Topcon TRC-50DX; captured after pupil dilation; 2228 by 1652 pixels:
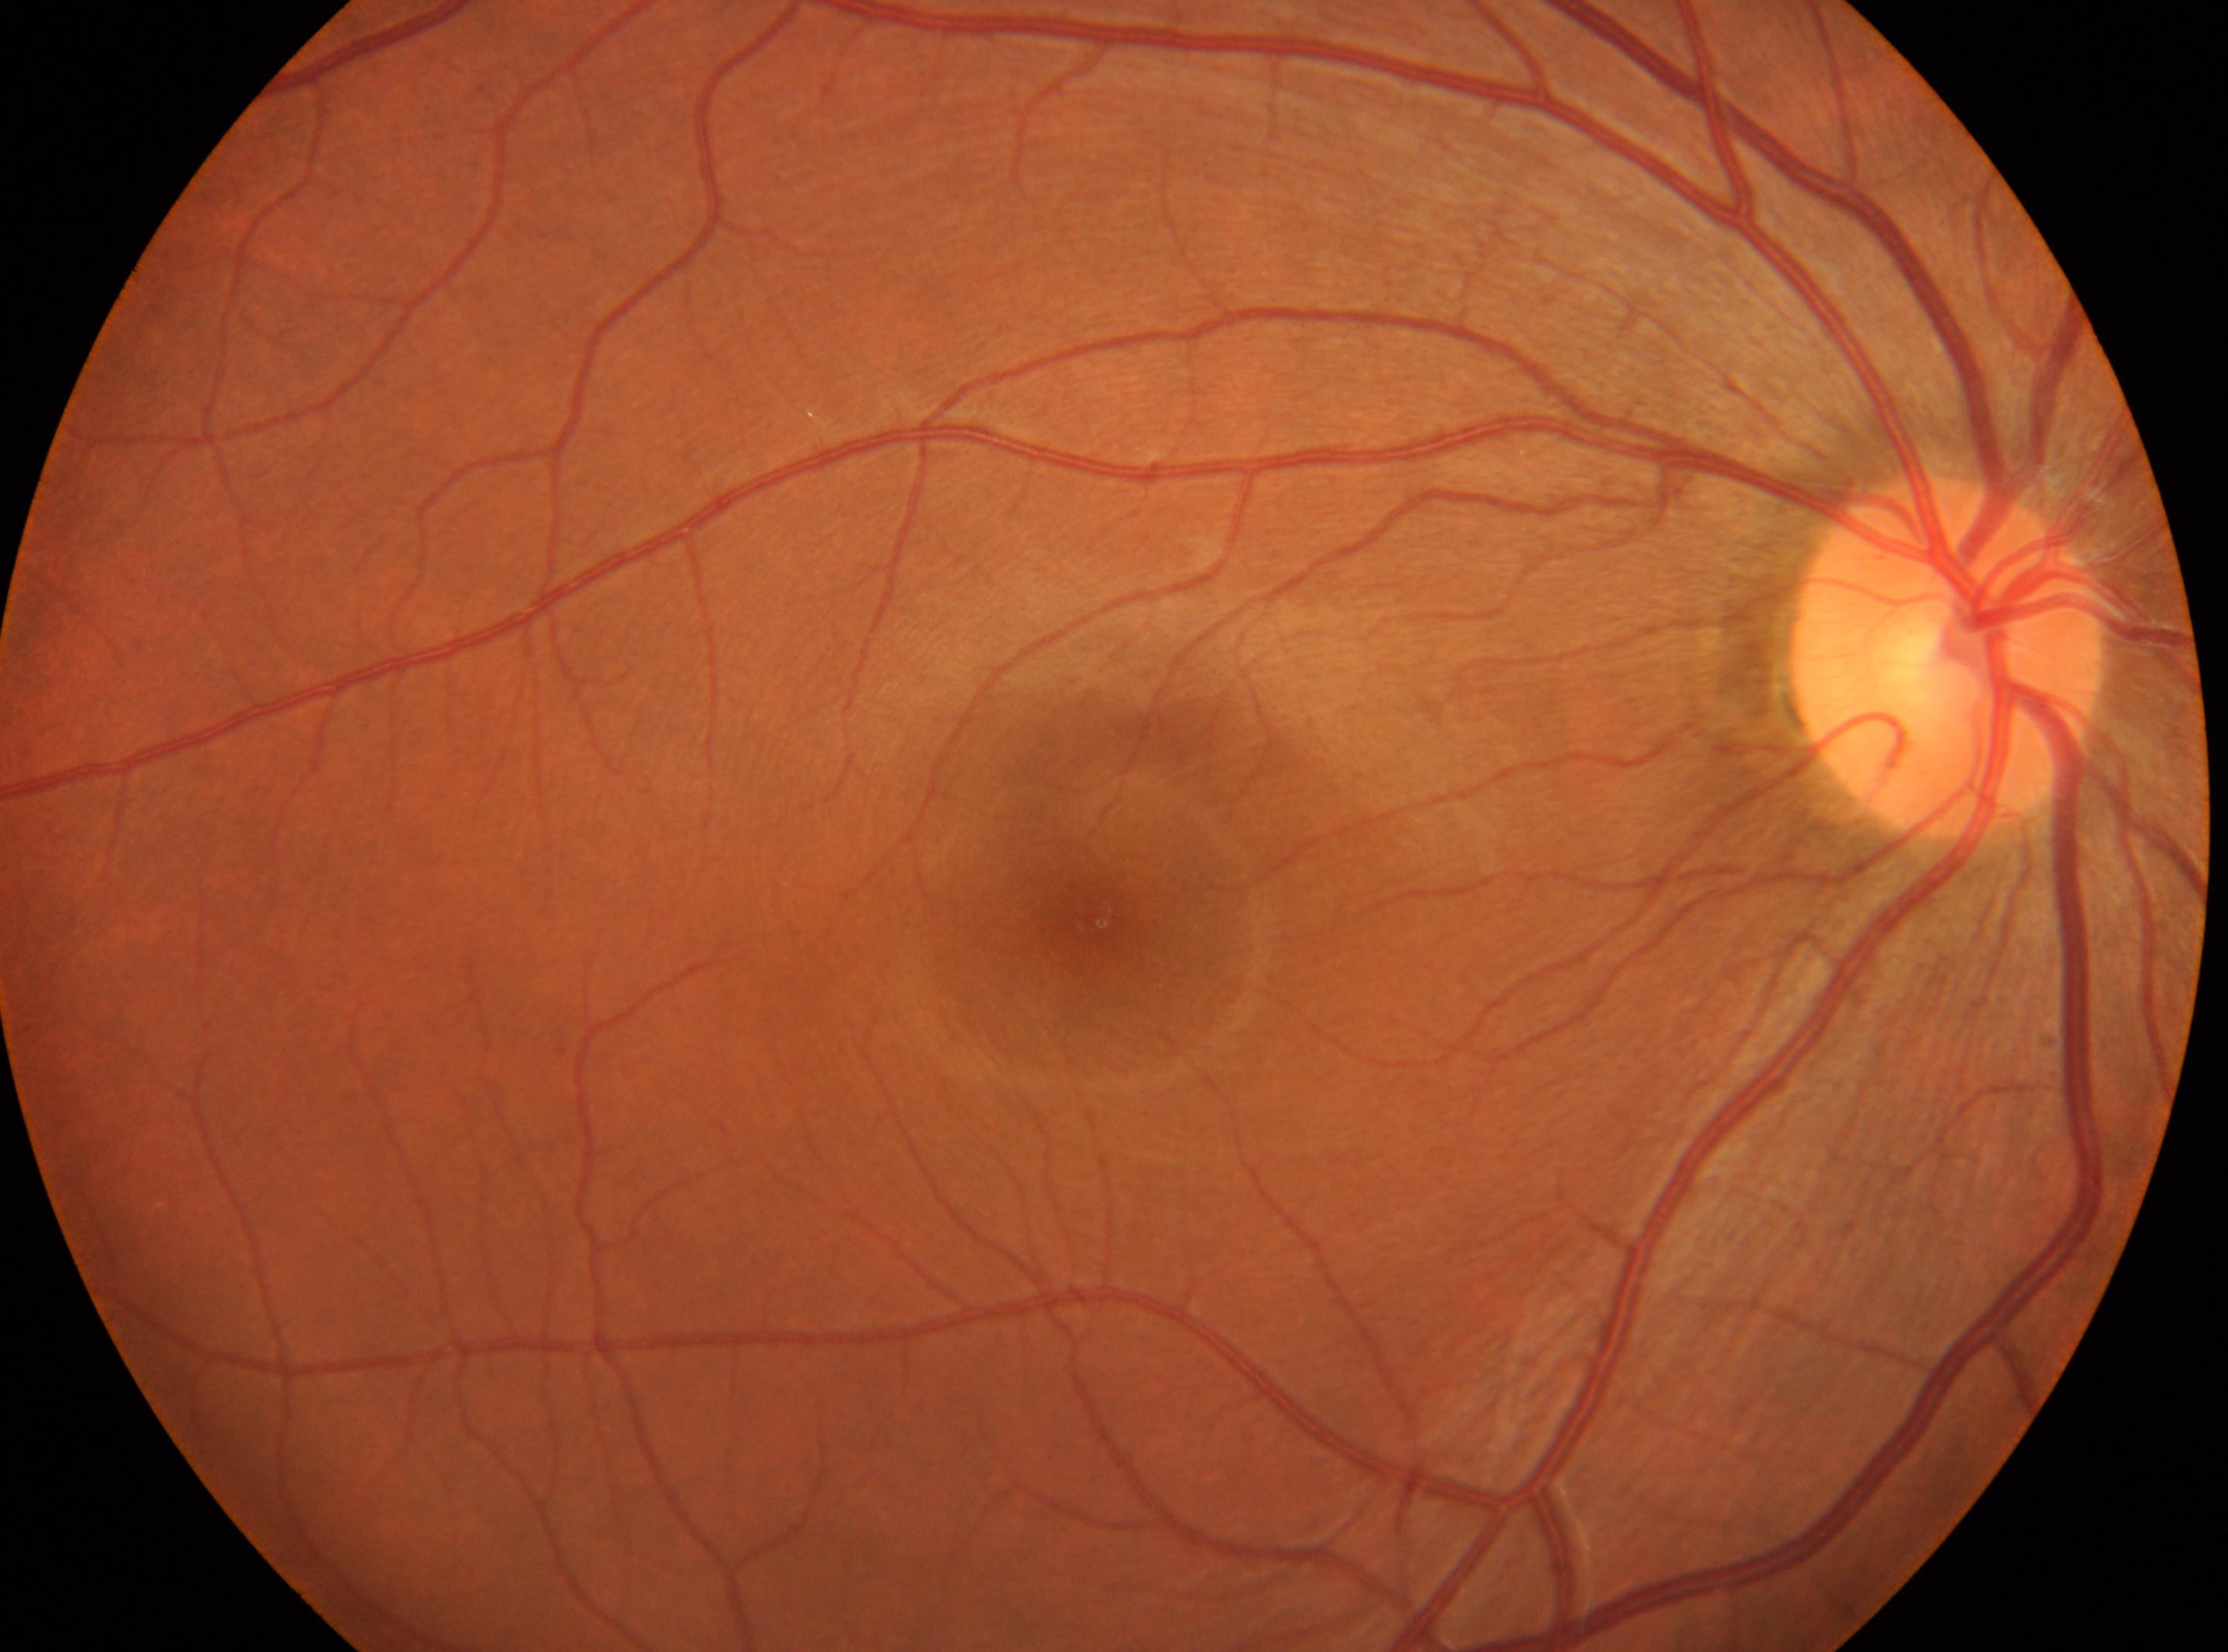
Fovea: (1094,914). This is the right eye. DR stage: 0 — no visible signs of diabetic retinopathy. Disc center: (1948,655). No signs of diabetic retinopathy.